FOV: 200 degrees. 1924x1556px. UWF retinal mosaic:
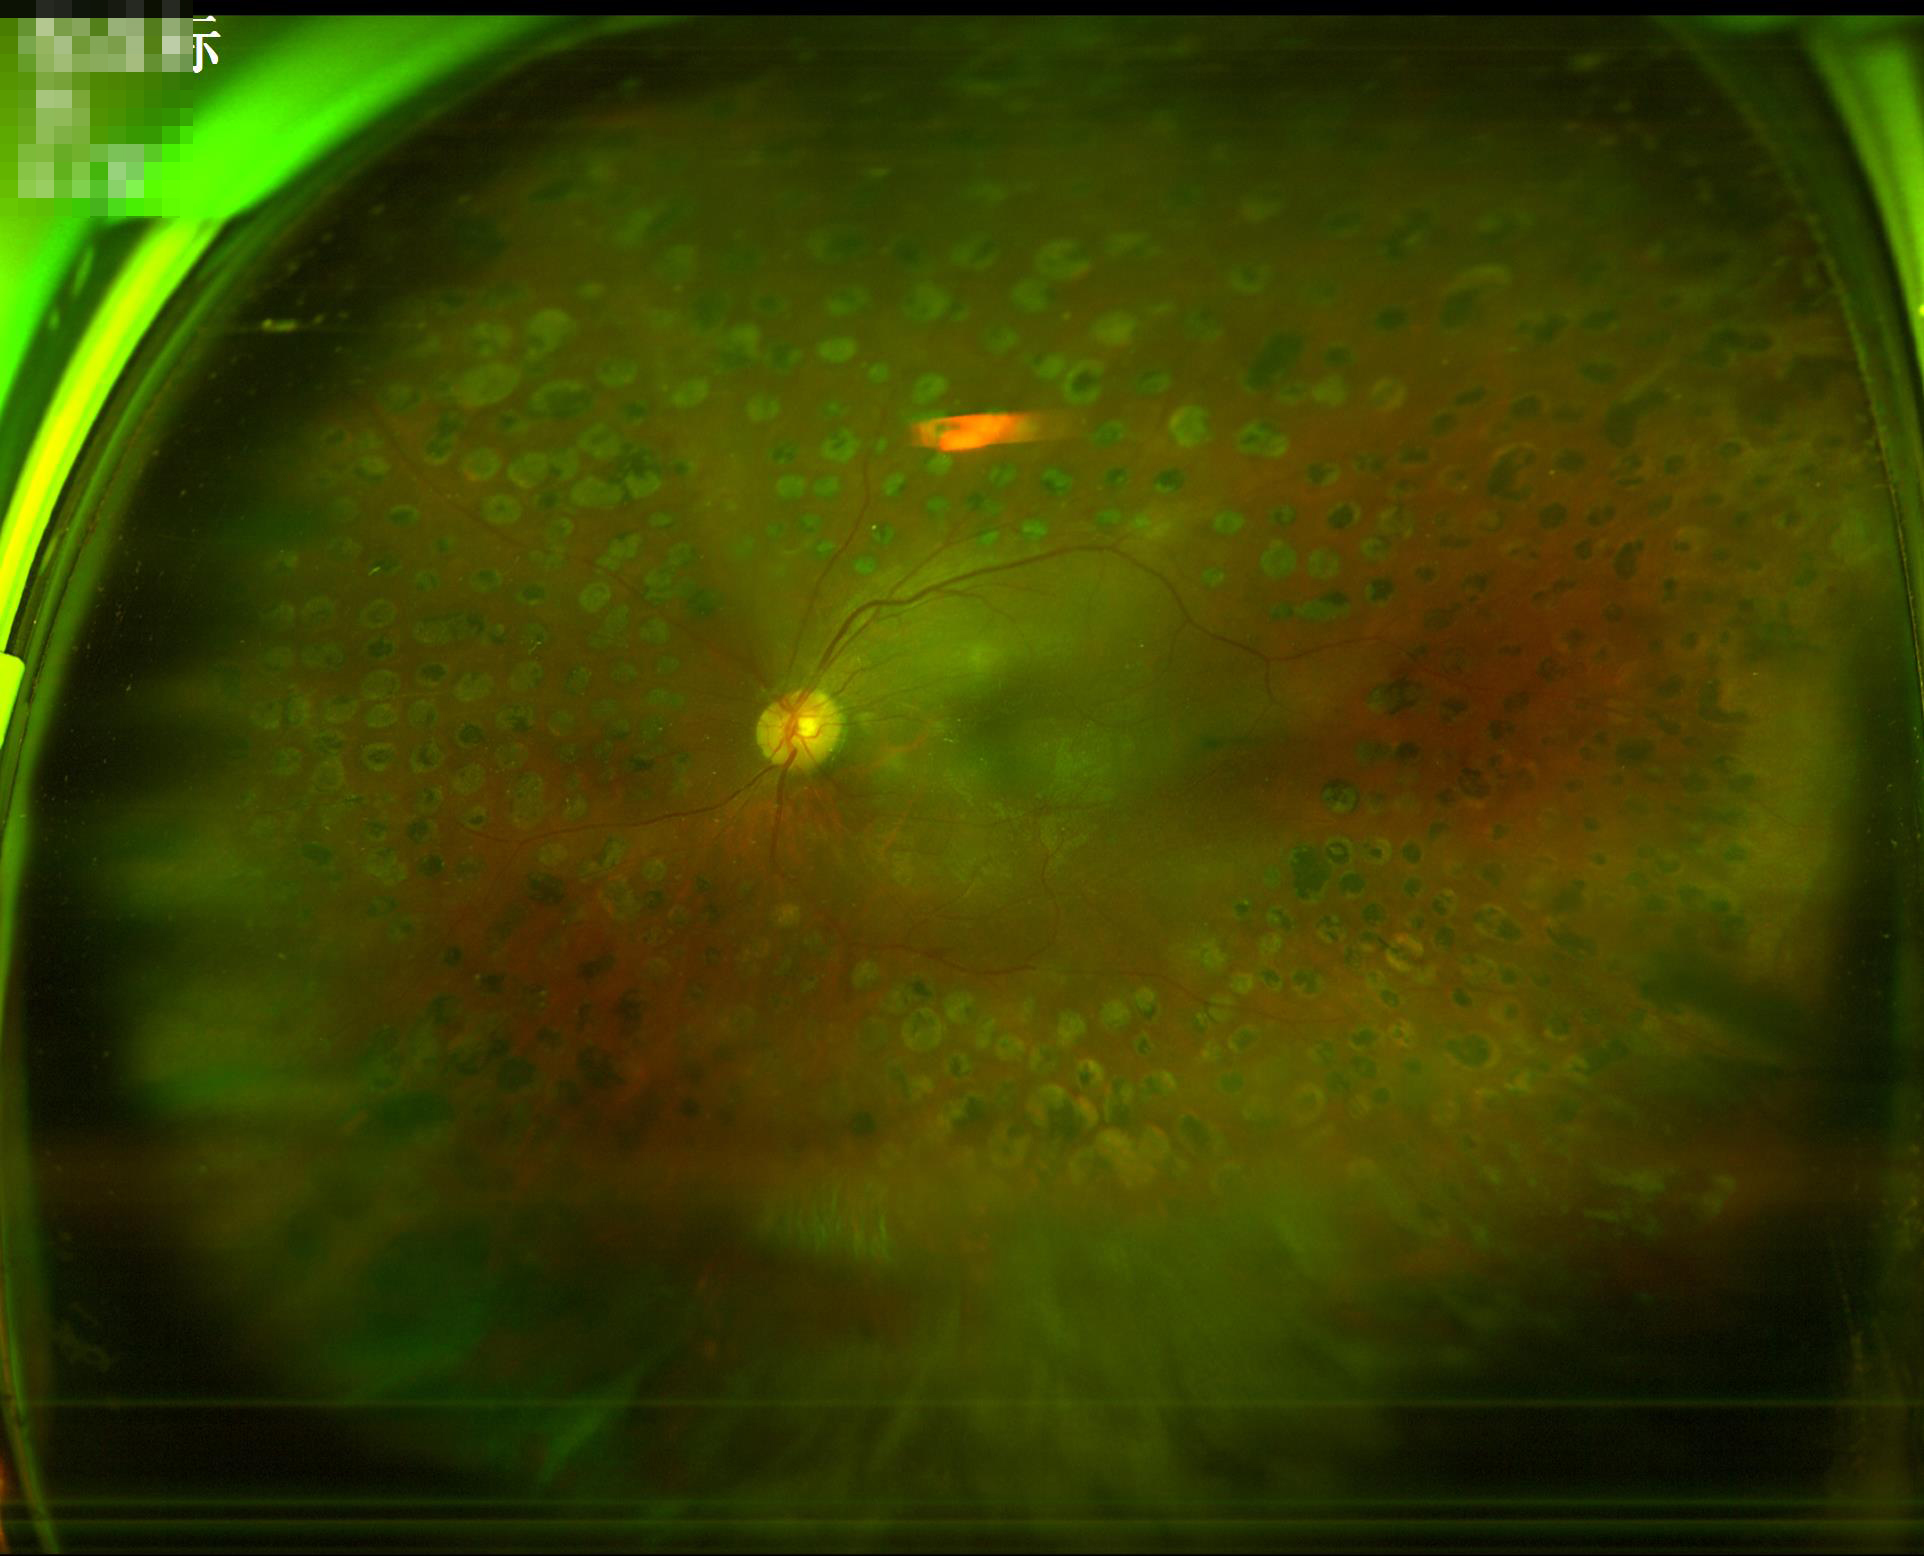 Image quality assessment:
- sharpness: reduced
- contrast: satisfactory
- illumination/color: adequate
- overall: poor